Wide-field fundus photograph from neonatal ROP screening; Natus RetCam Envision, 130° FOV: 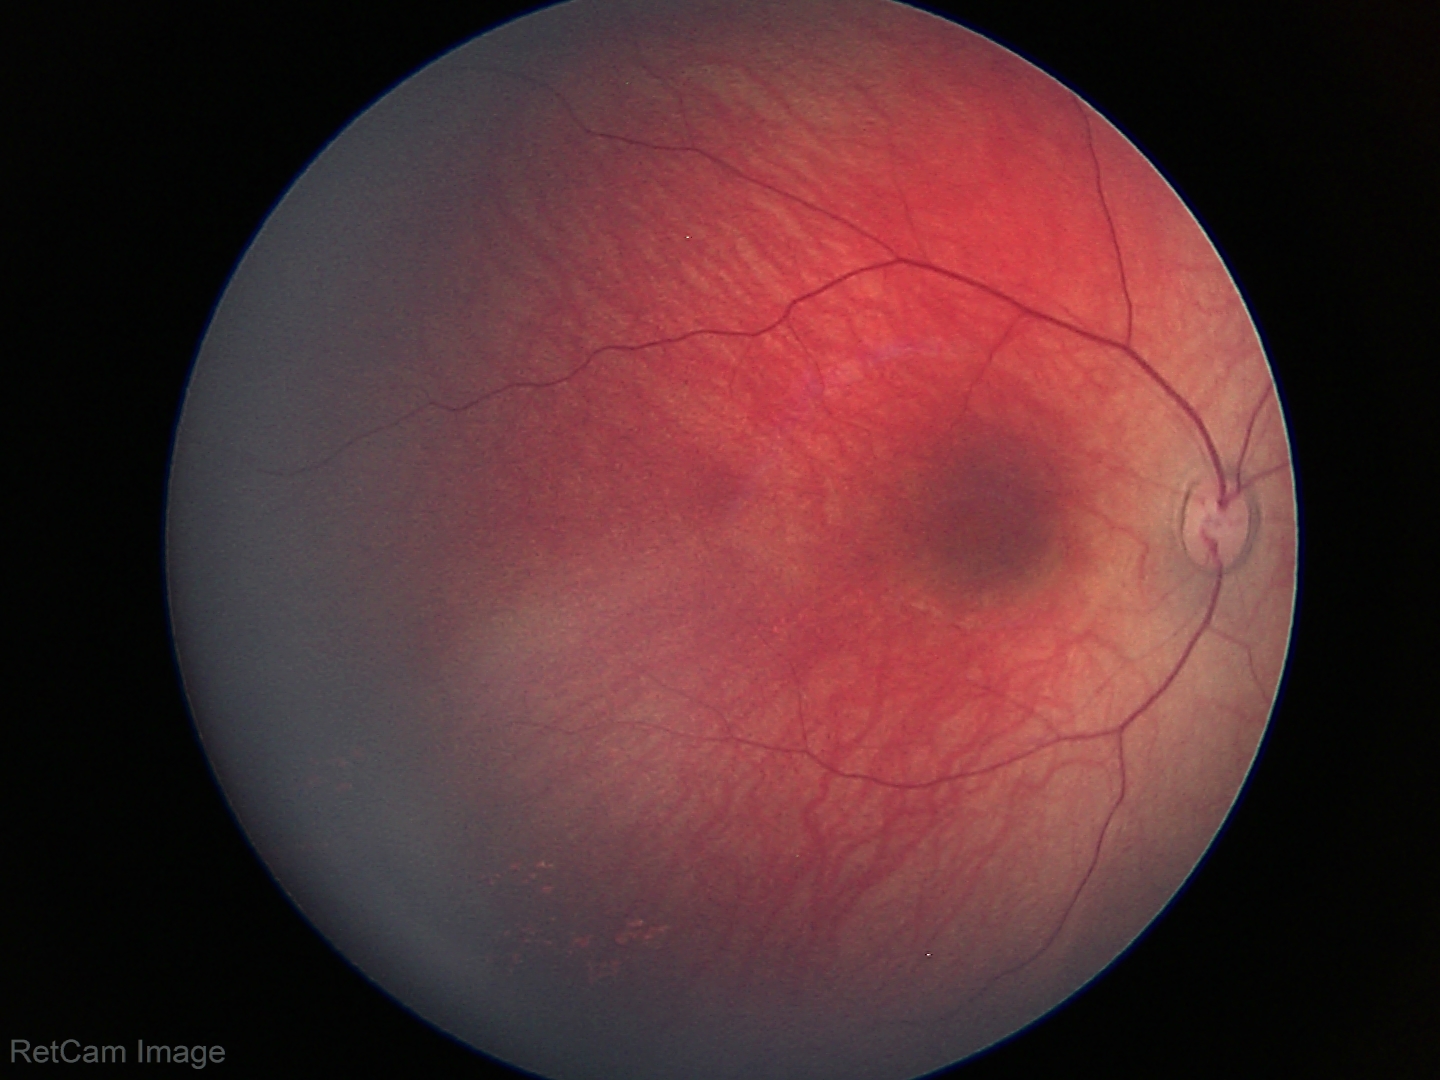

Screening examination diagnosed as physiological.